45° field of view:
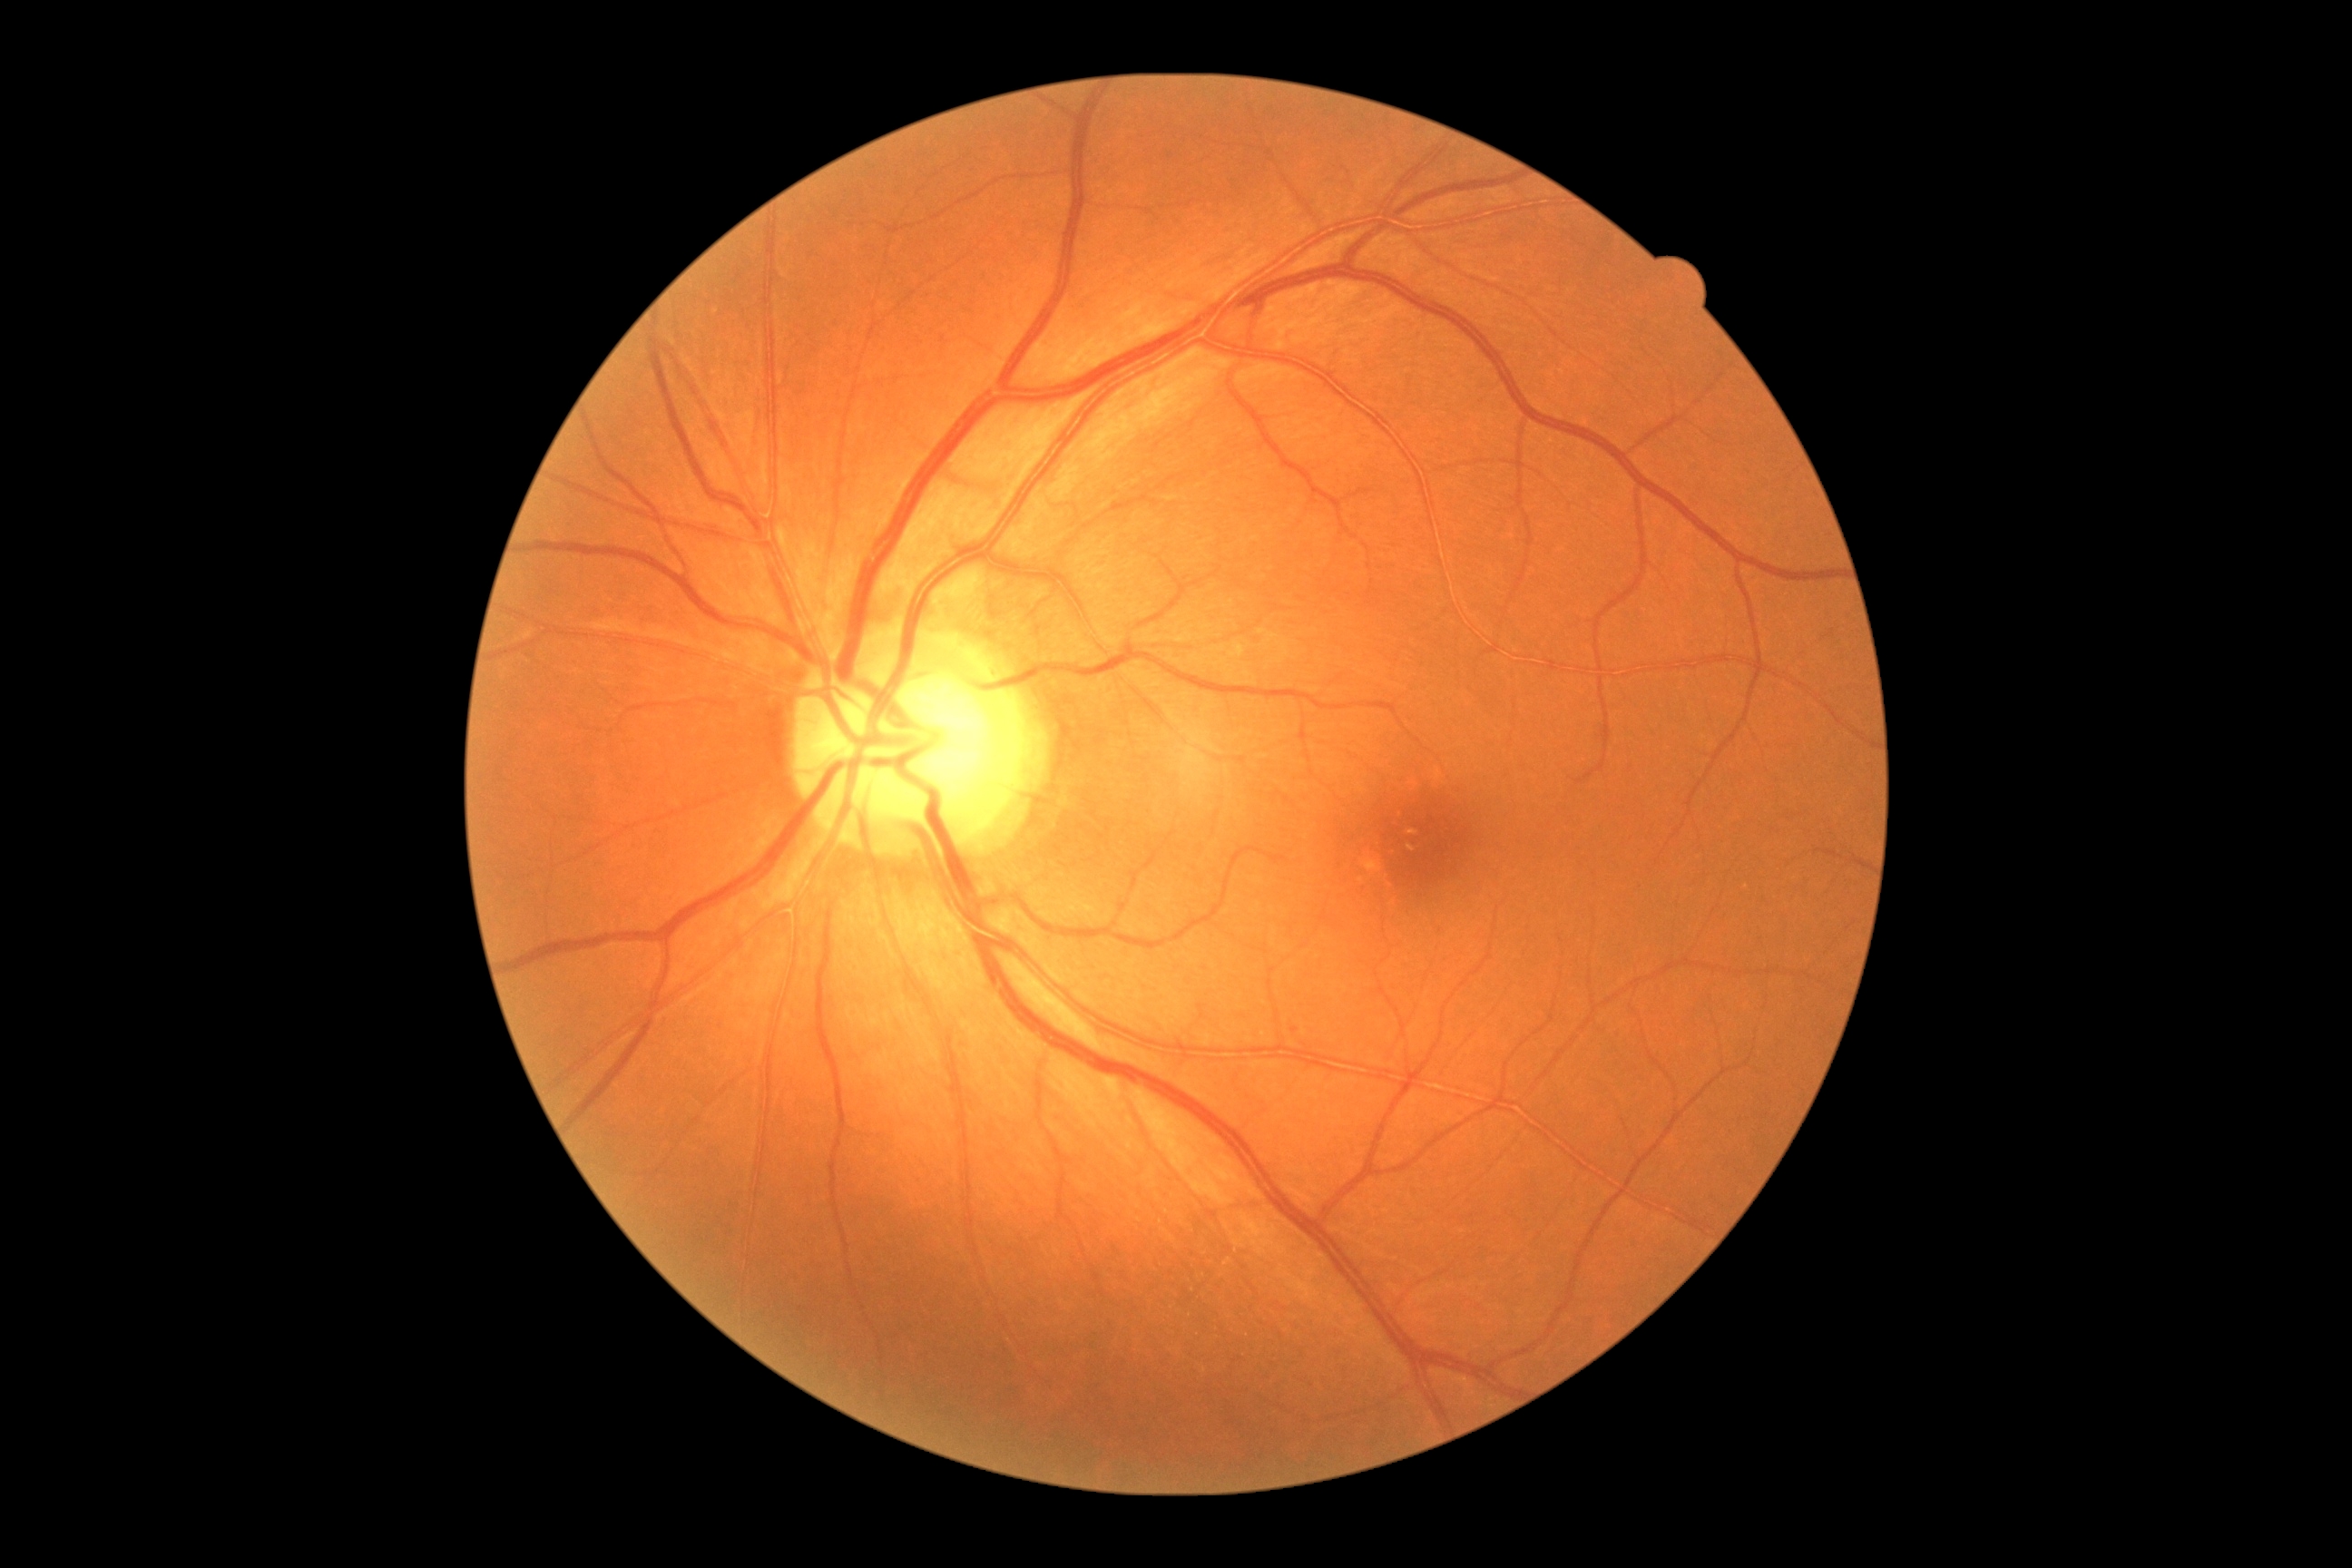 DR stage = no apparent diabetic retinopathy (grade 0)
DR impression = no apparent DR